50-degree field of view.
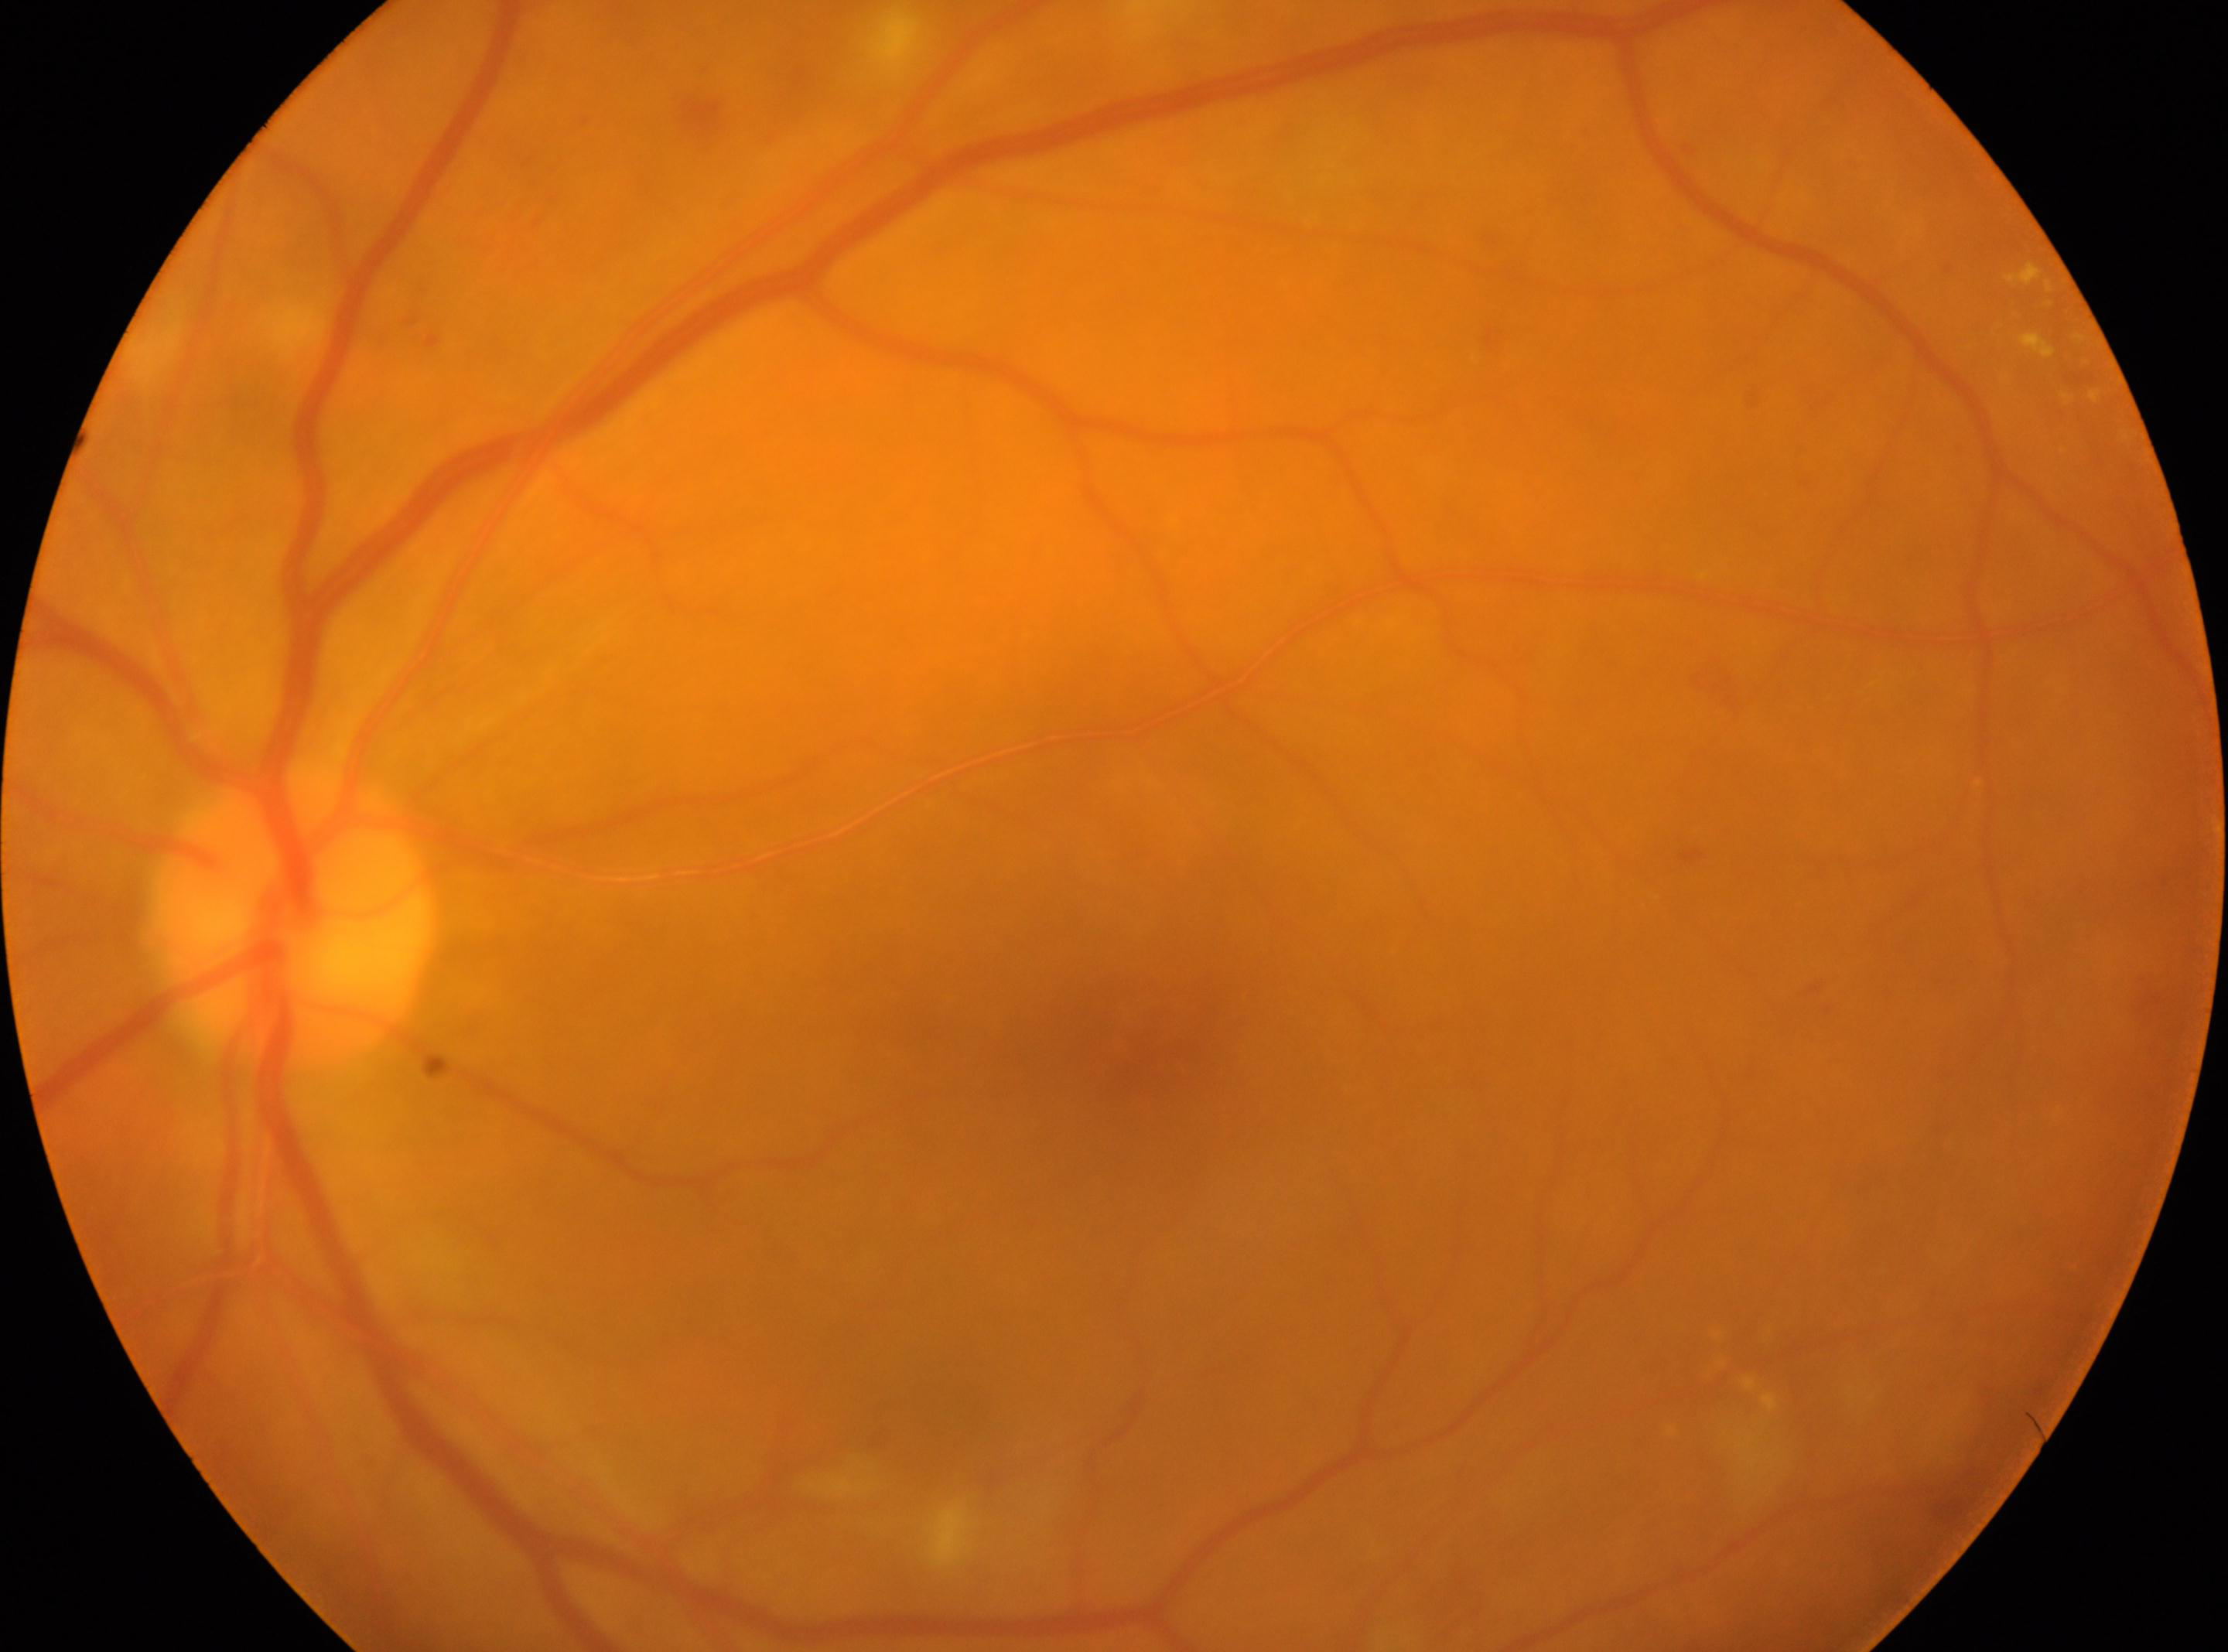 Optic disc center located at 292px, 914px. The image shows the oculus sinister. Diabetic retinopathy grade is moderate NPDR (2). The foveal center is at 1114px, 1060px.